Color fundus photograph; nonmydriatic — 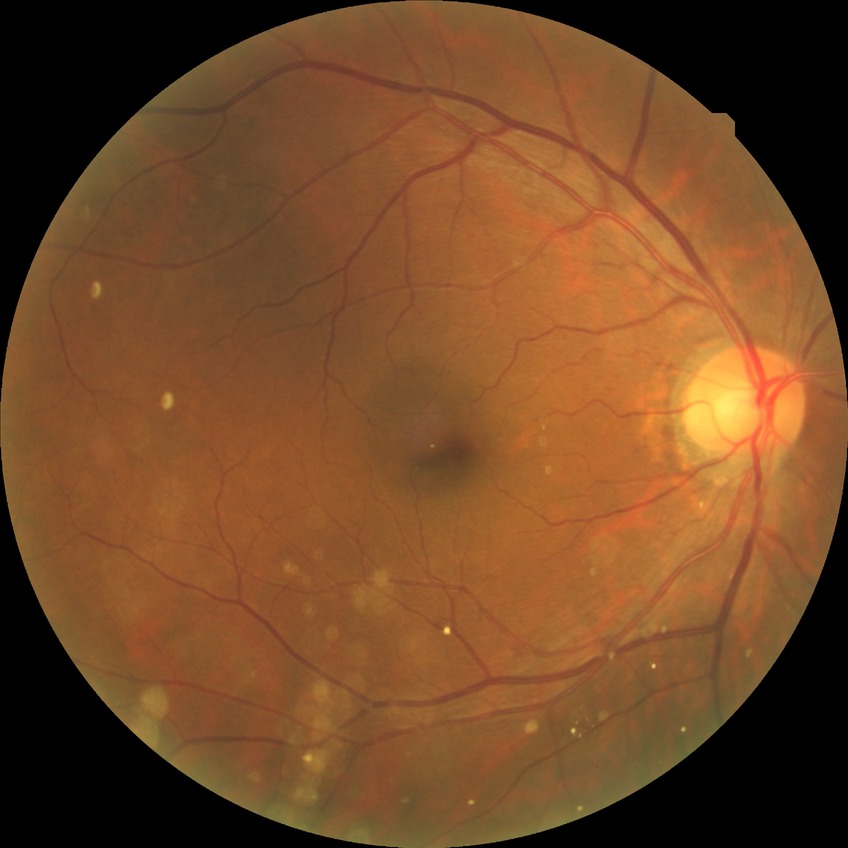
Retinopathy grade: no diabetic retinopathy.